No pharmacologic dilation · 848 x 848 pixels · posterior pole color fundus photograph · 45° field of view · camera: NIDEK AFC-230: 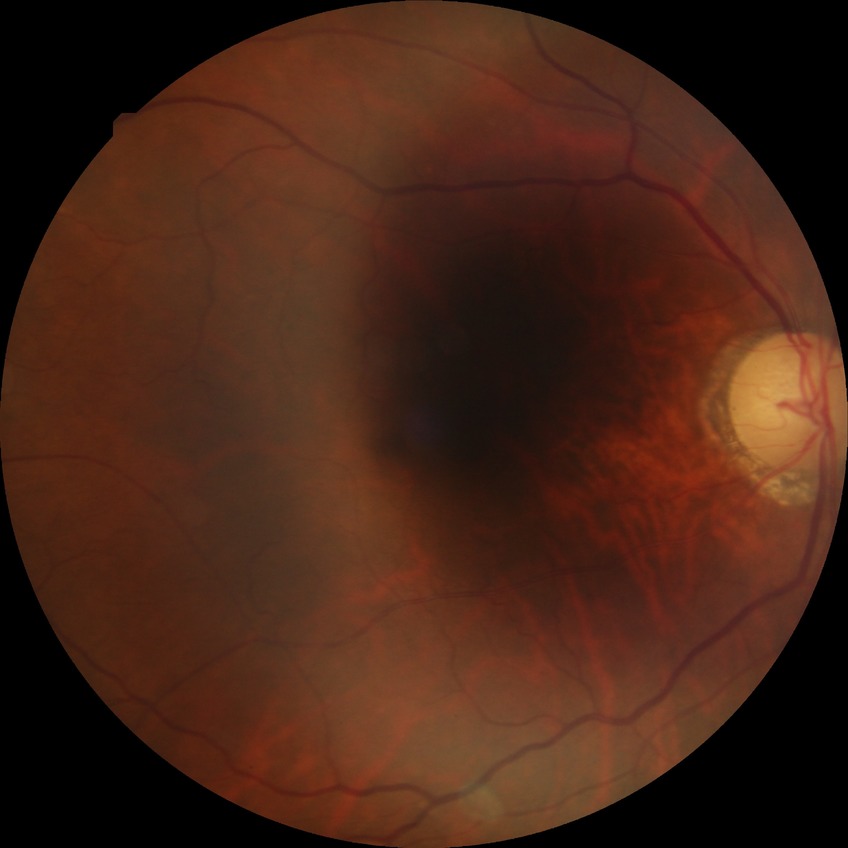

Diabetic retinopathy (DR) is NDR (no diabetic retinopathy).